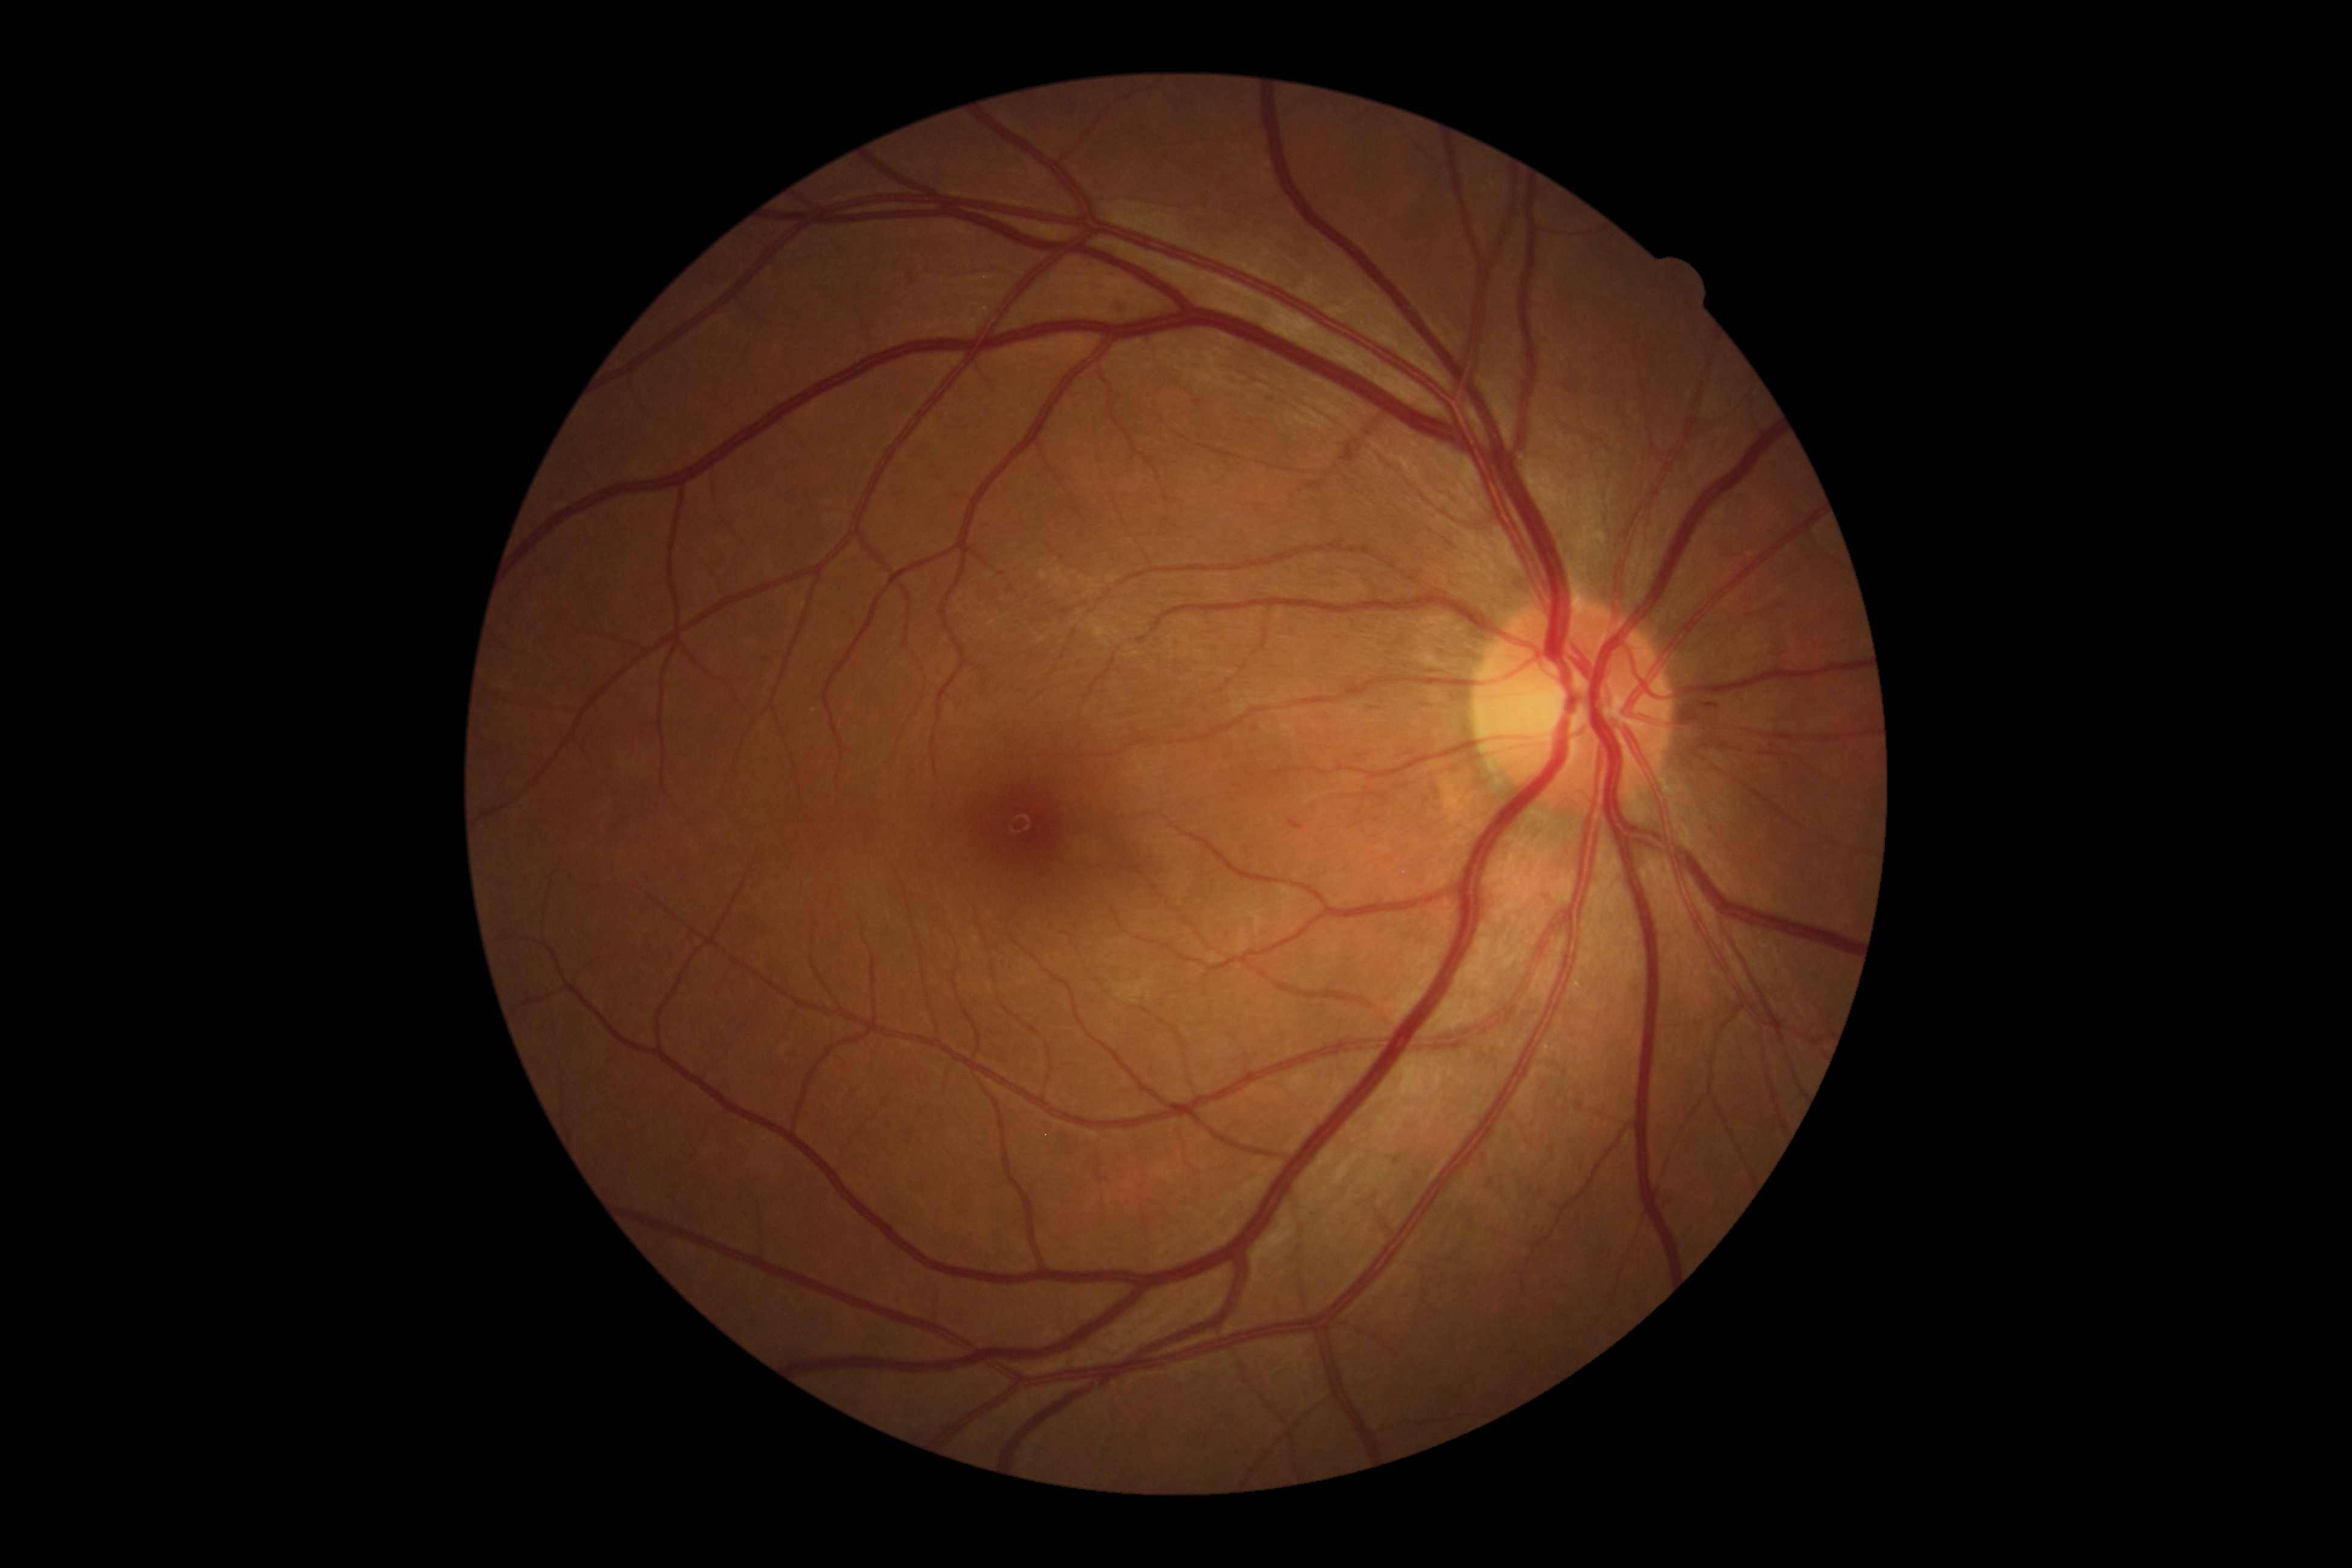

DR class: non-proliferative diabetic retinopathy
diabetic retinopathy: 2/4